45° FOV. Color fundus image. 848 by 848 pixels. NIDEK AFC-230 fundus camera. No pharmacologic dilation — 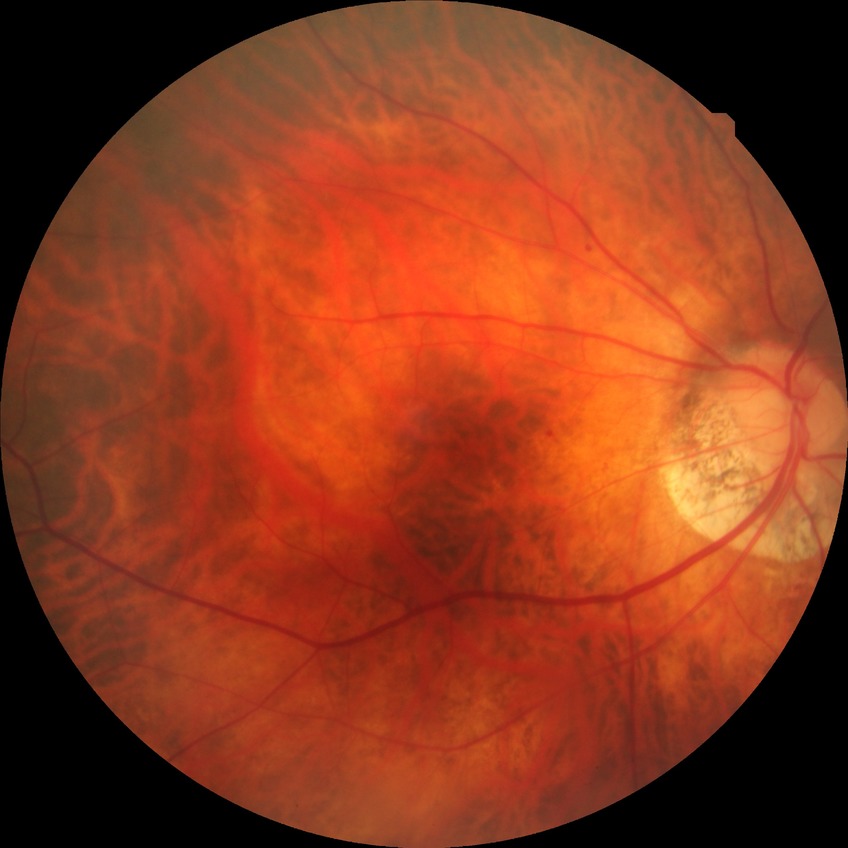
{"davis_grade": "NDR (no diabetic retinopathy)"}